1932x1932, FOV: 45 degrees, color fundus photograph:
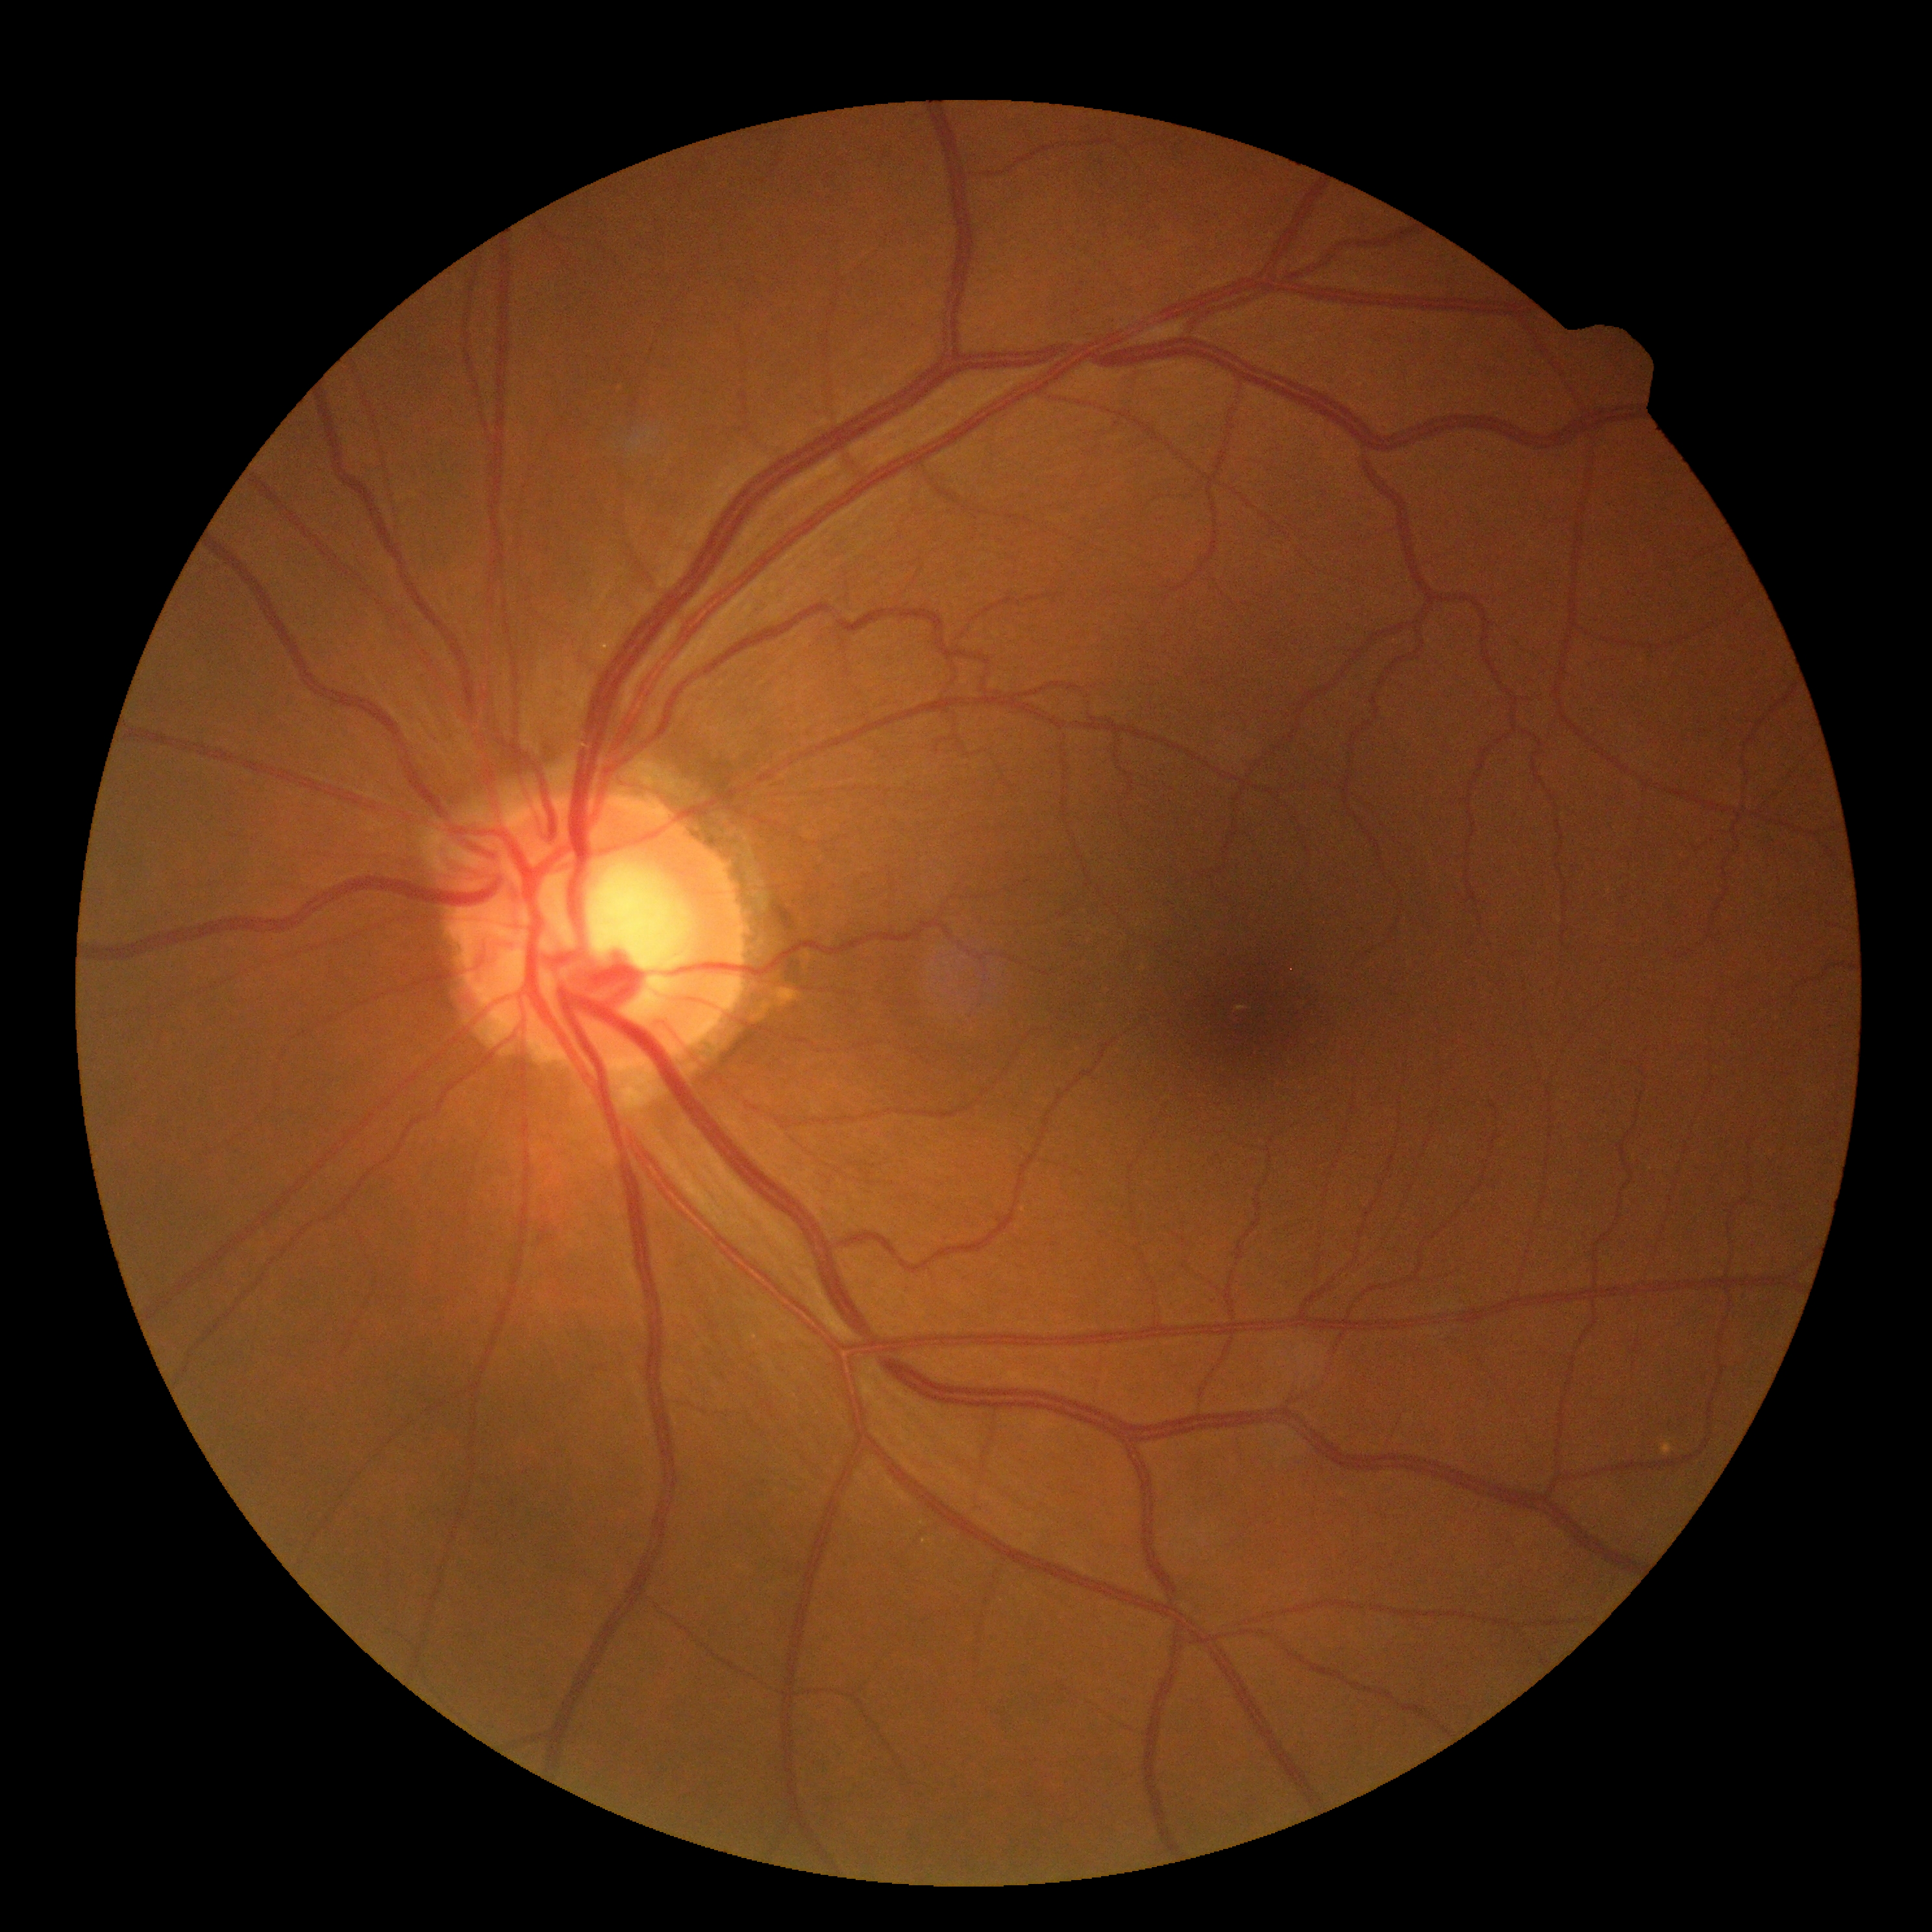
diabetic retinopathy (DR) = grade 0 (no apparent retinopathy)